Wide-field fundus photograph from neonatal ROP screening; 1440x1080px: 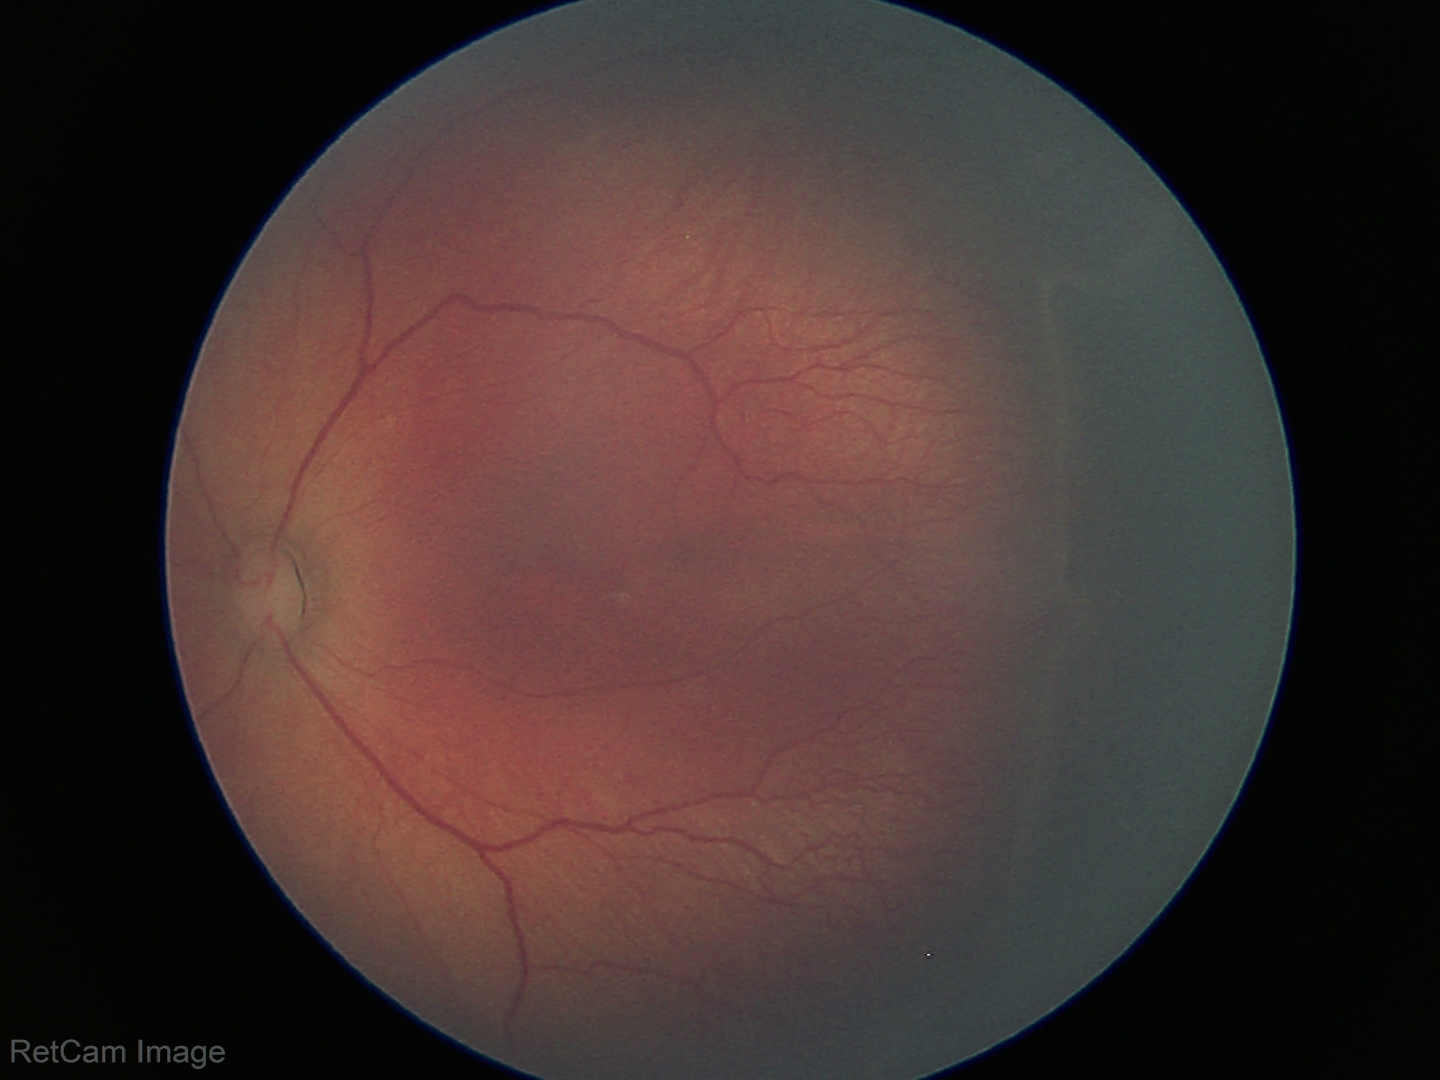
Q: Plus disease status?
A: no plus disease
Q: What is the screening diagnosis?
A: retinopathy of prematurity stage 2